Pediatric wide-field fundus photograph; camera: Phoenix ICON (100° FOV): 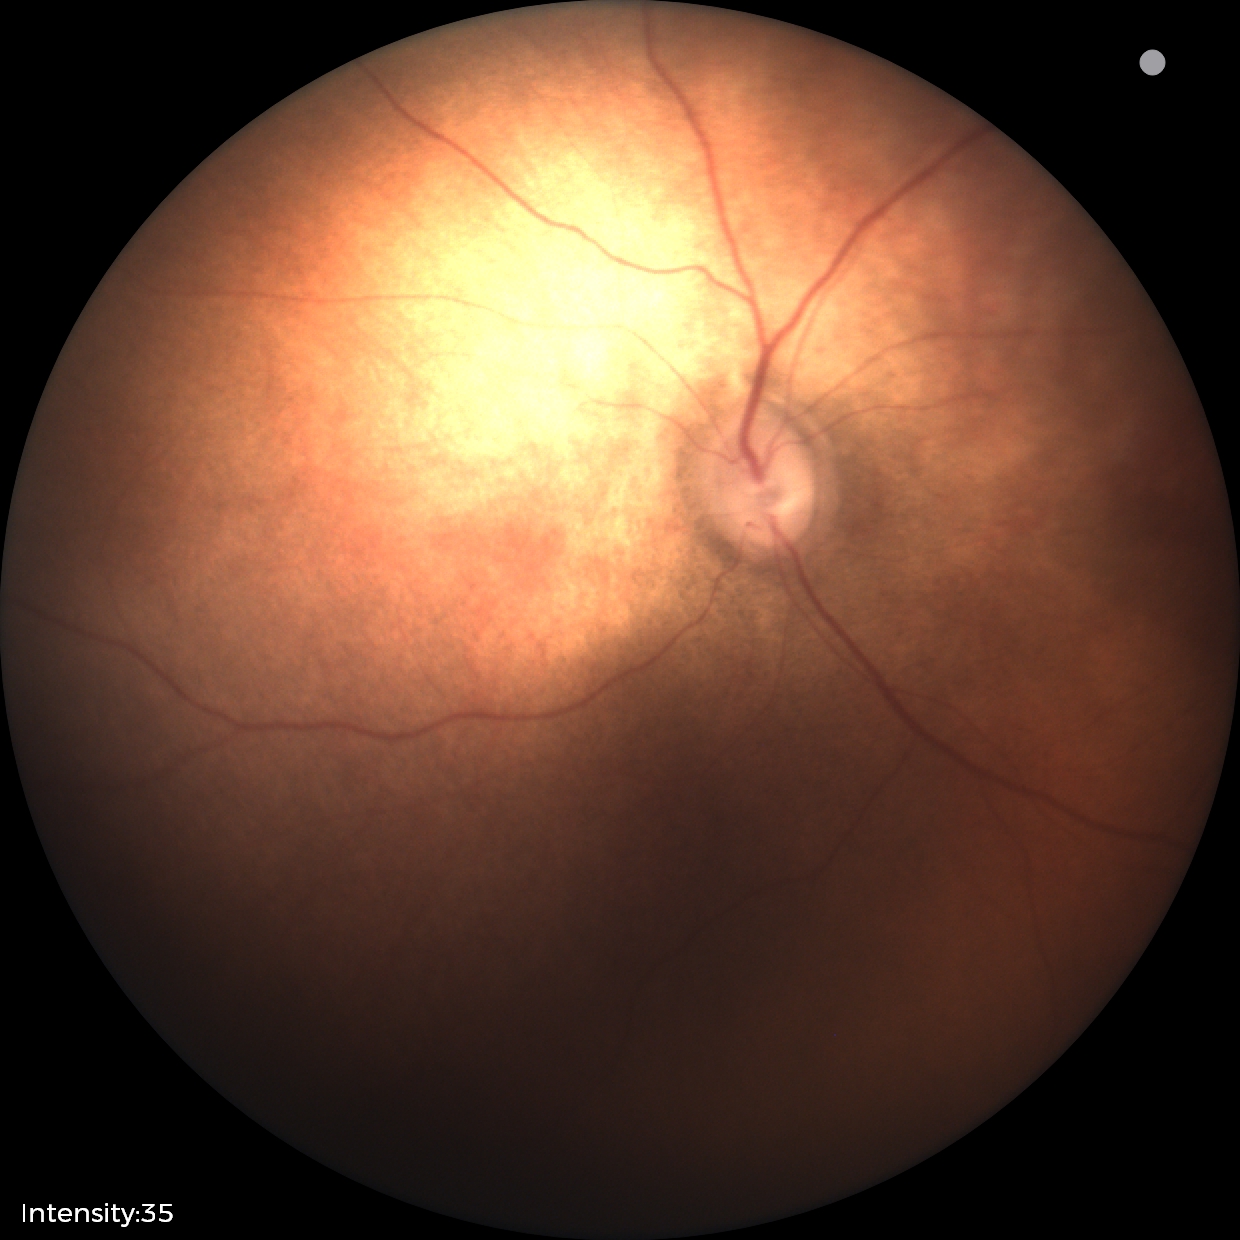

Normal screening examination.